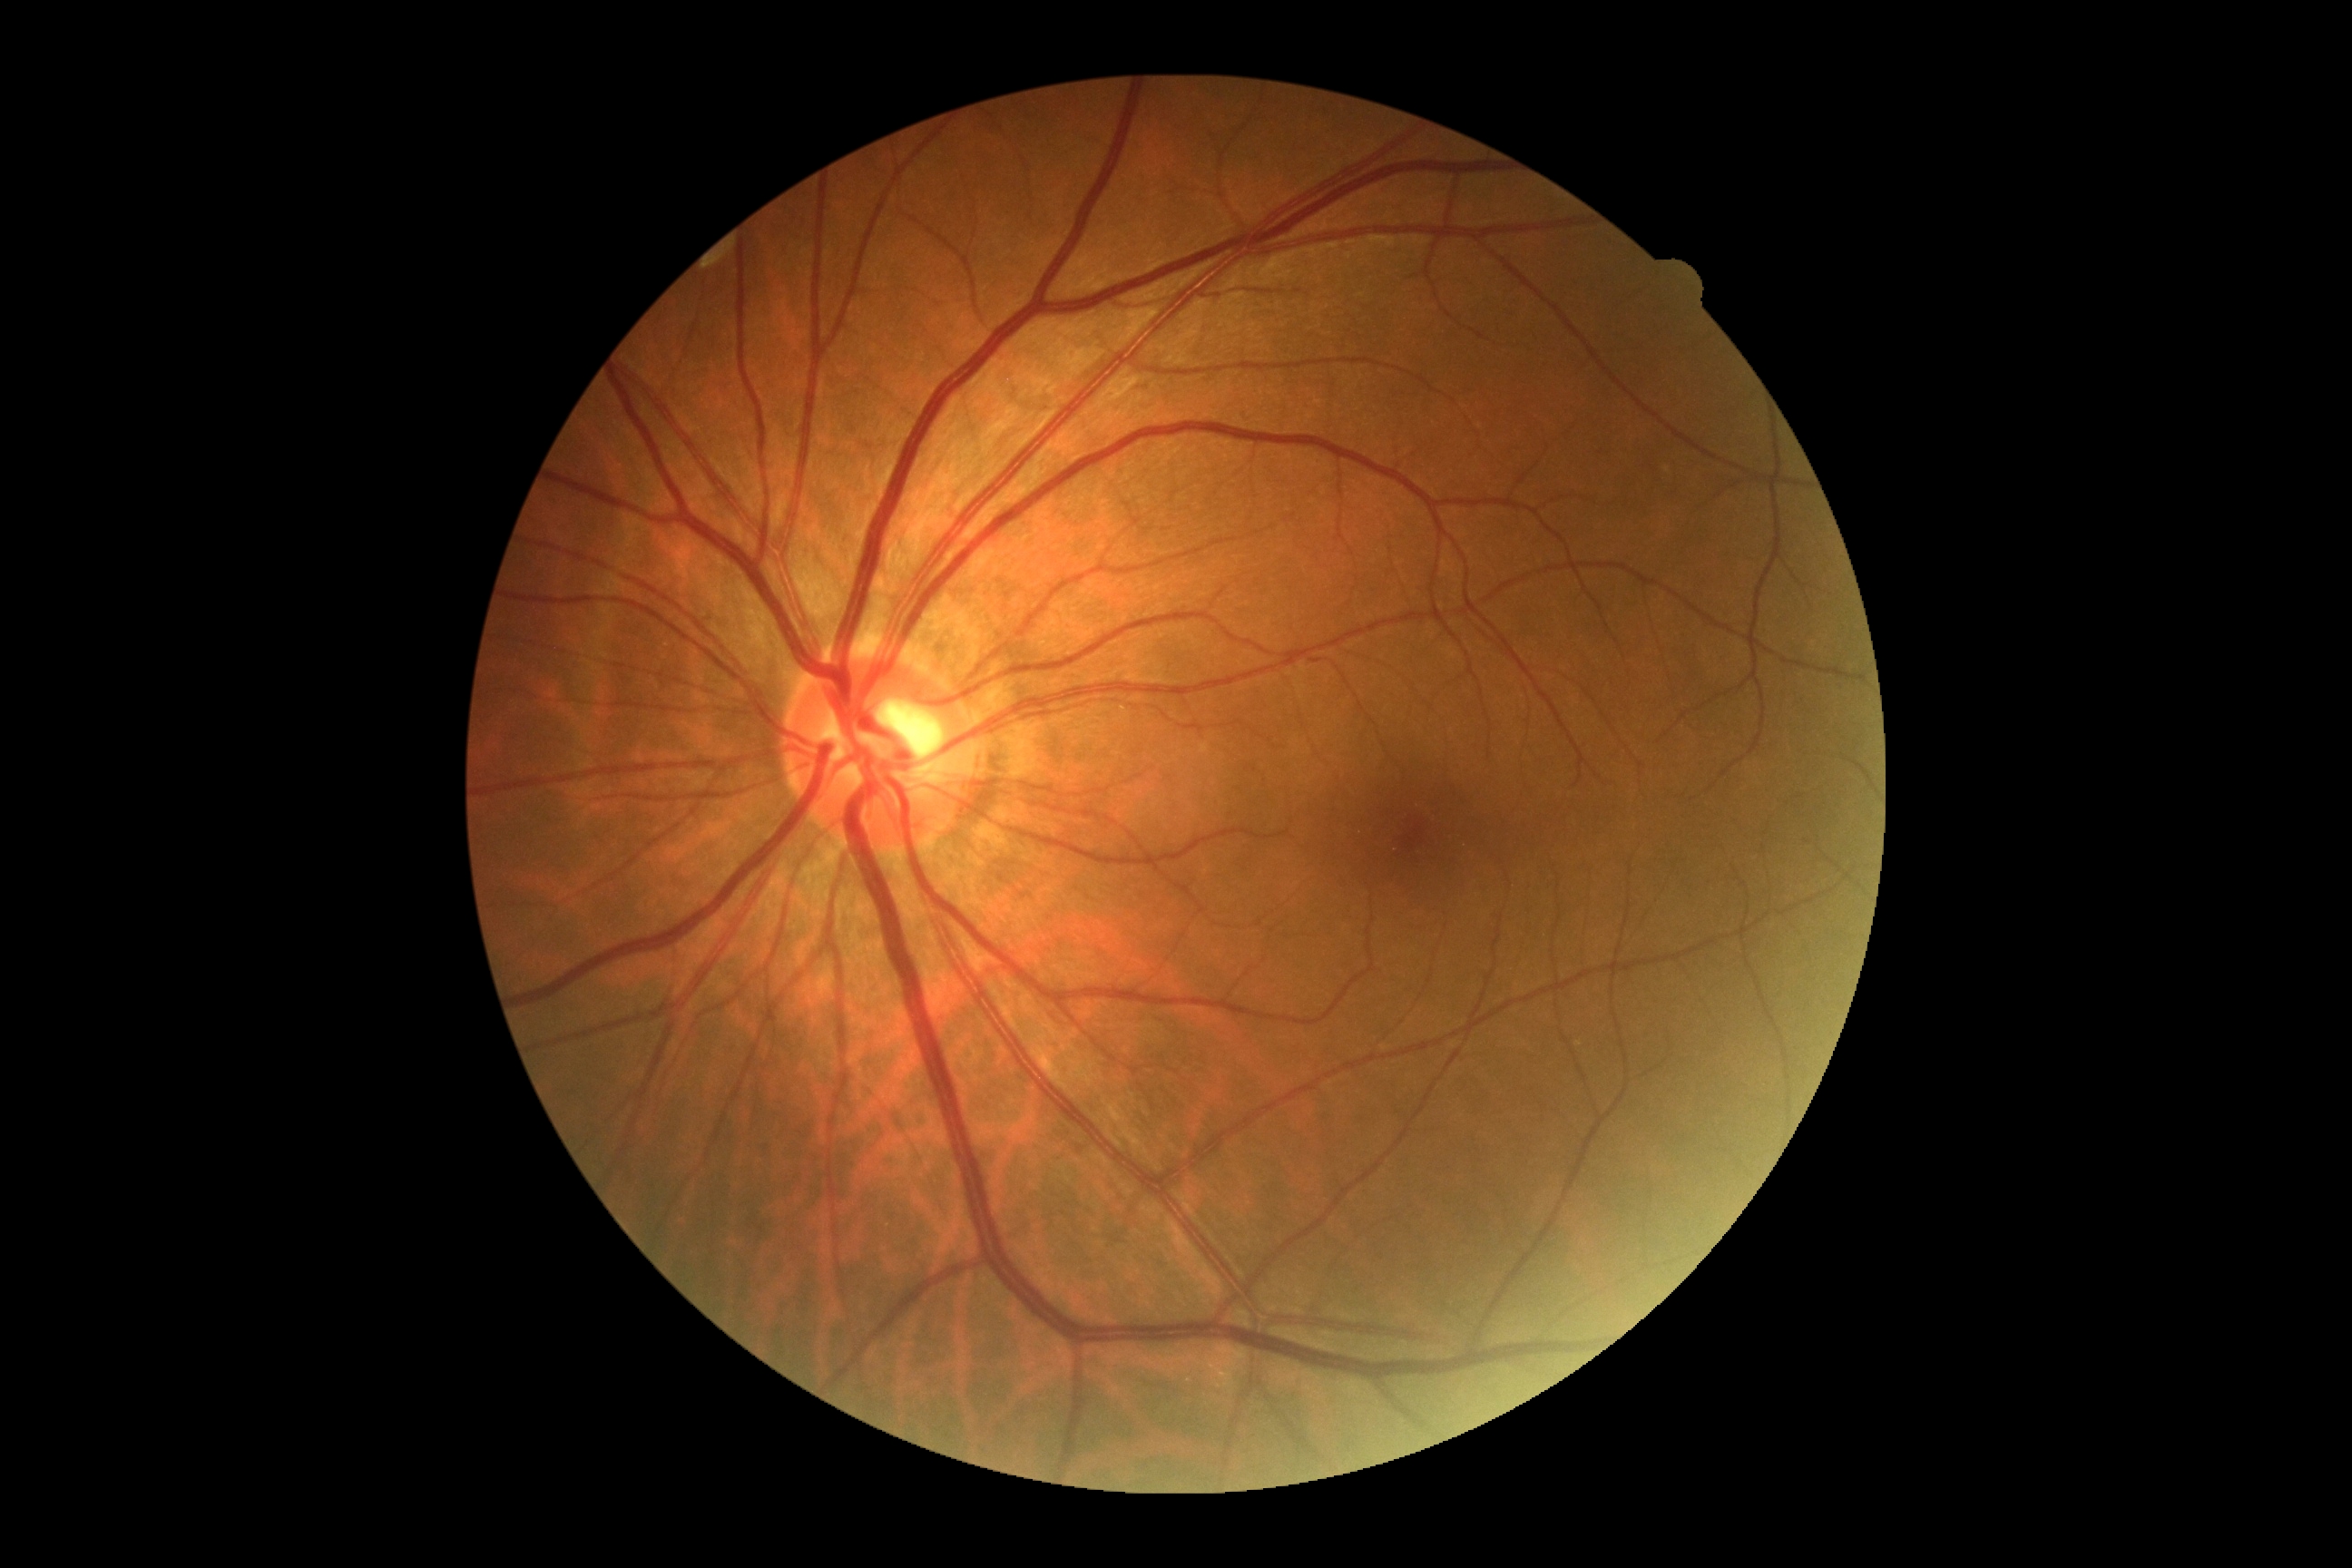 Annotations:
– DR impression: no DR findings
– diabetic retinopathy severity: 0/4